45° field of view
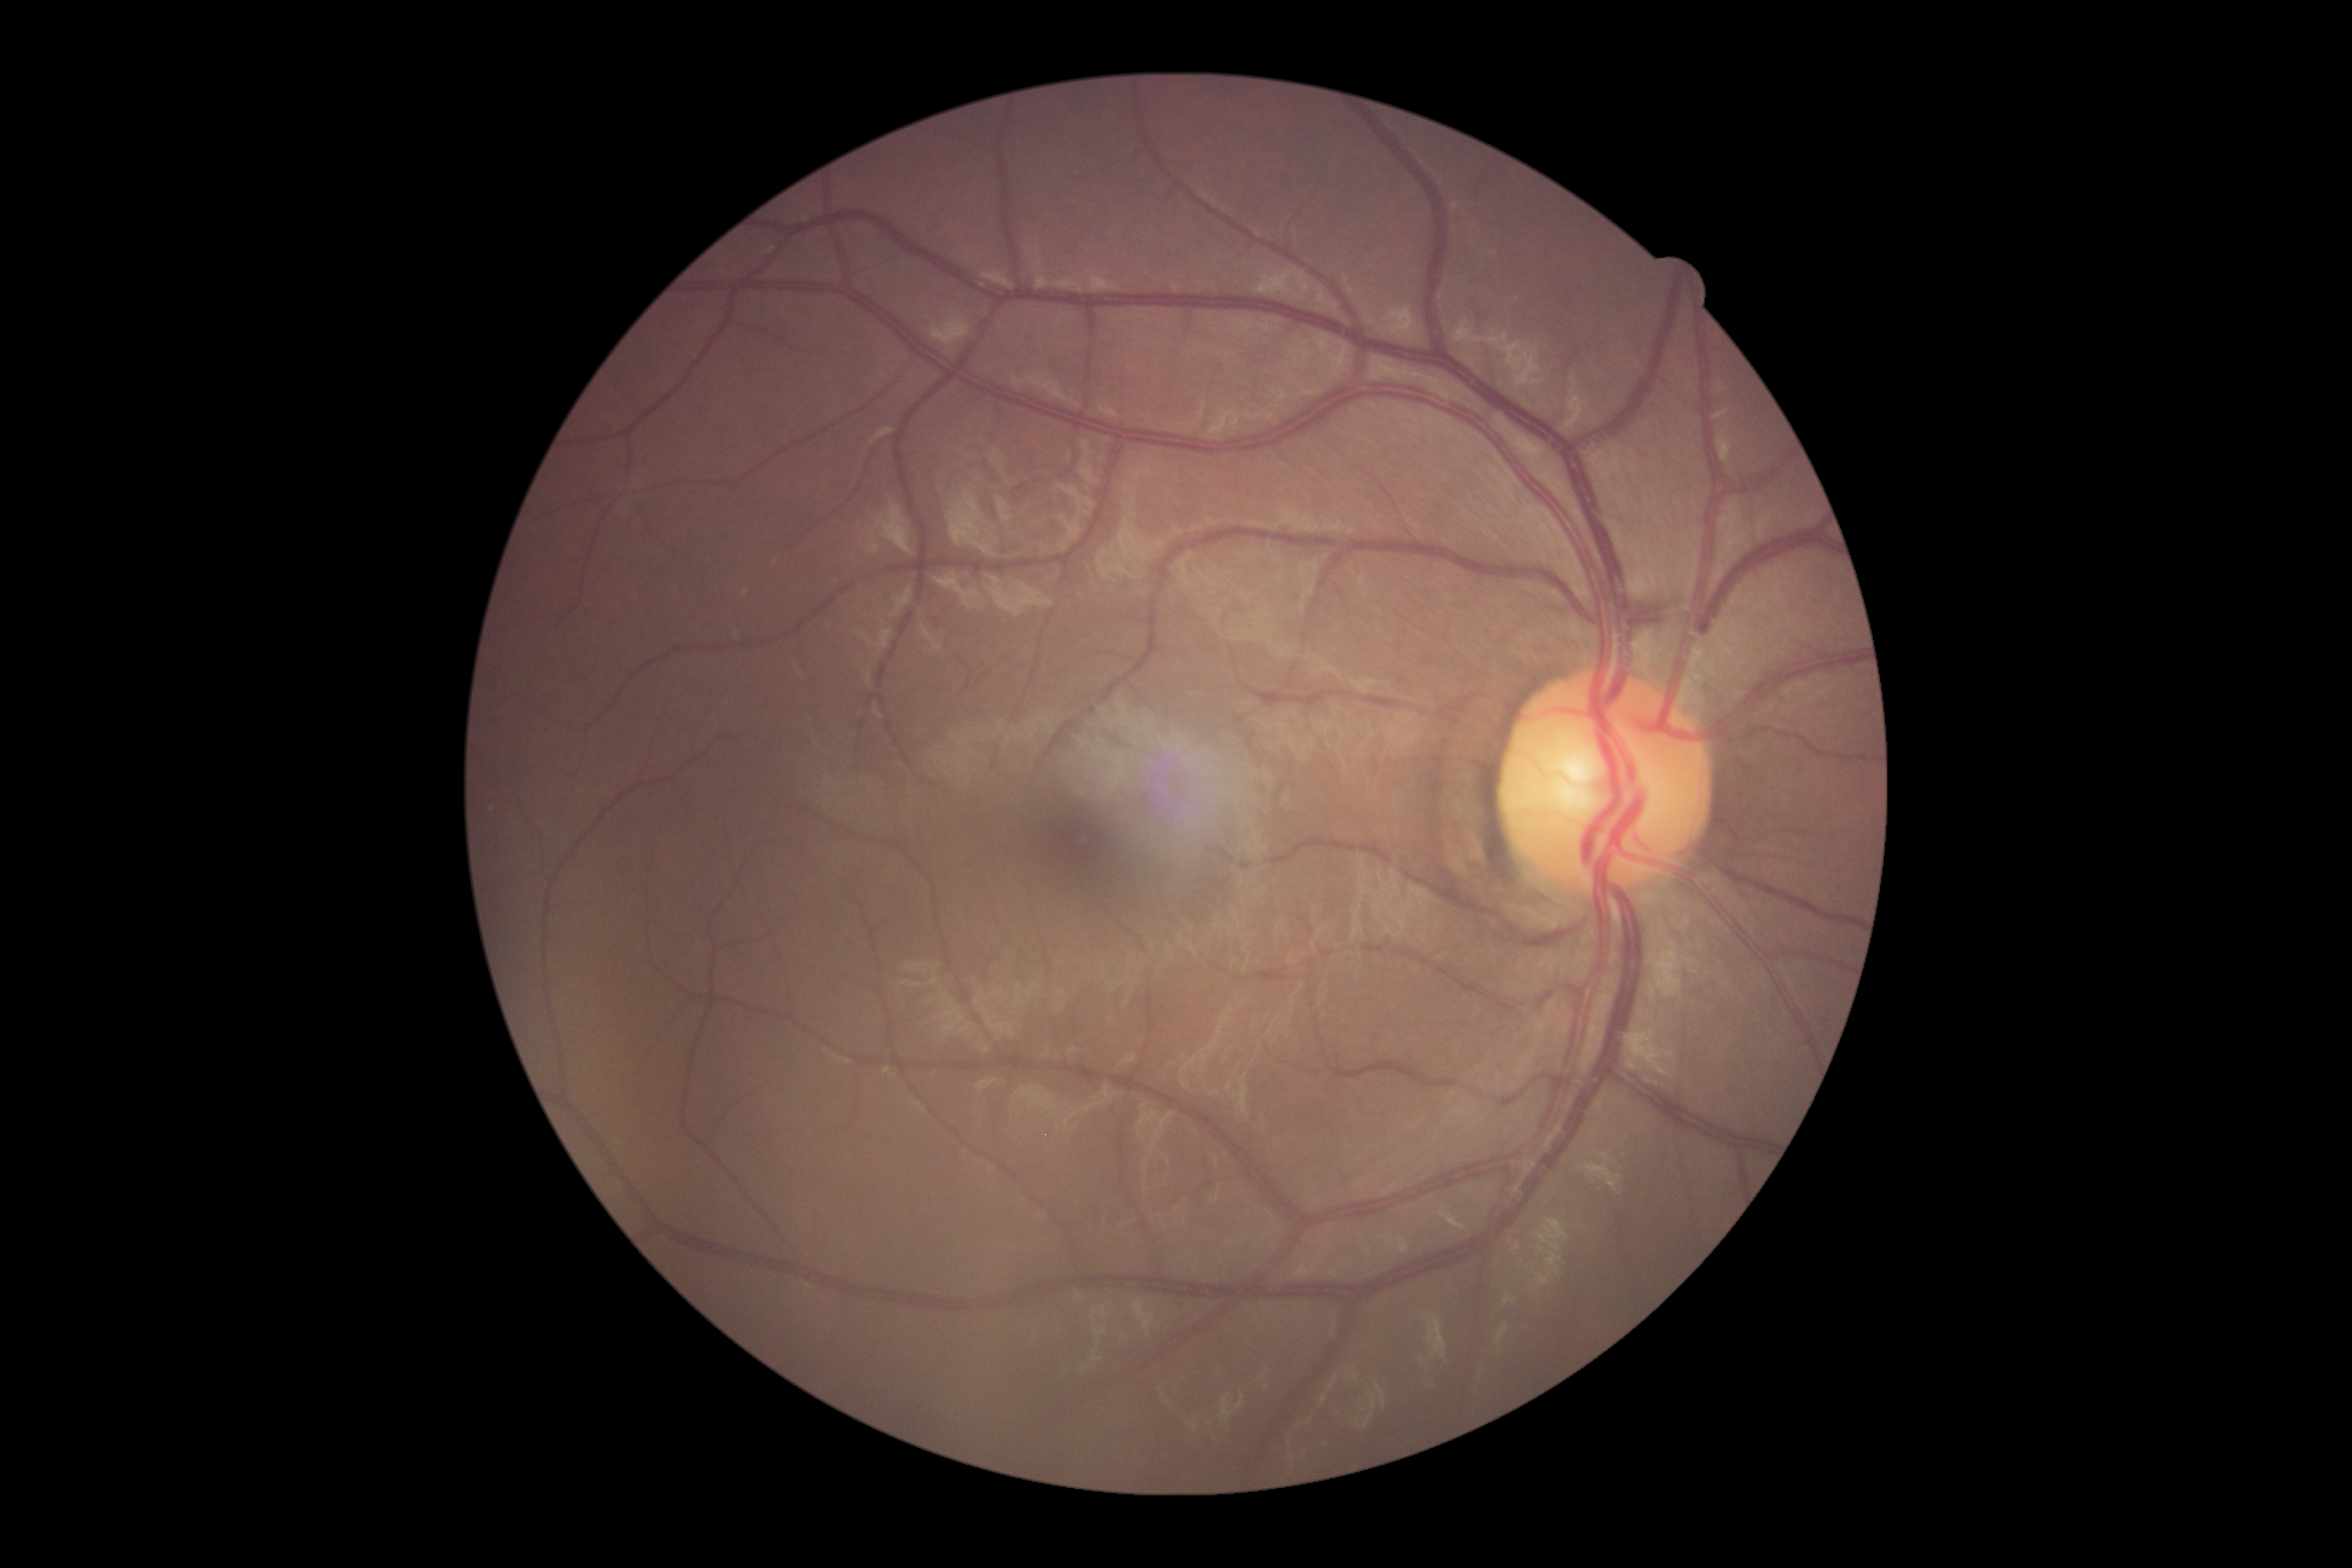 Findings:
- DR impression — negative for DR
- diabetic retinopathy grade — 0